45° field of view · no pharmacologic dilation · modified Davis classification
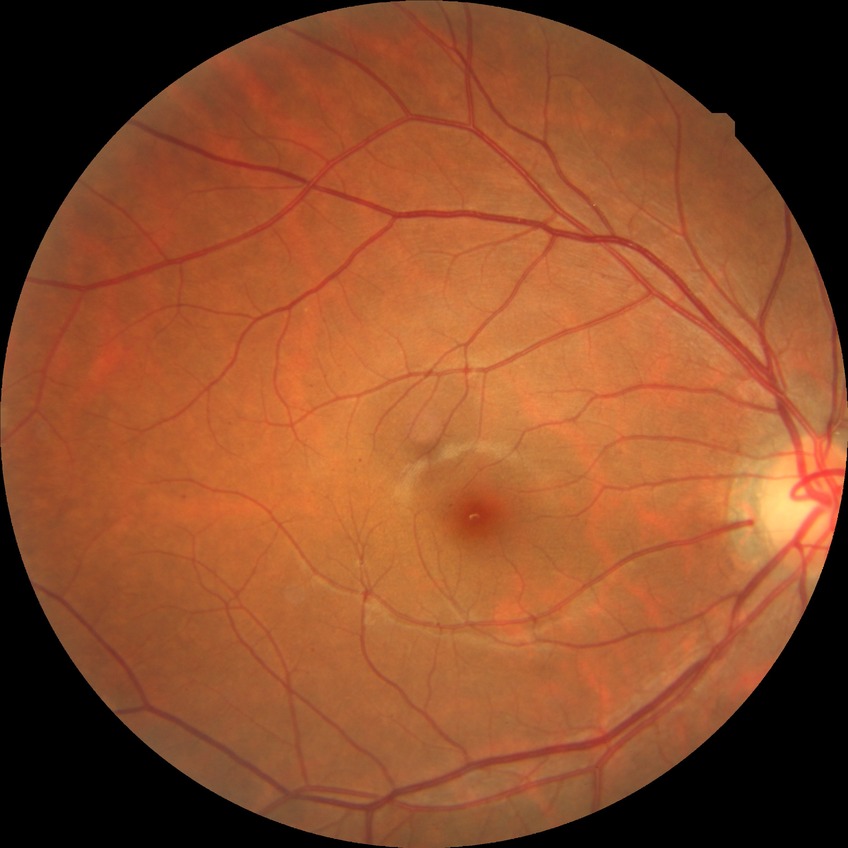 Modified Davis classification: simple diabetic retinopathy.